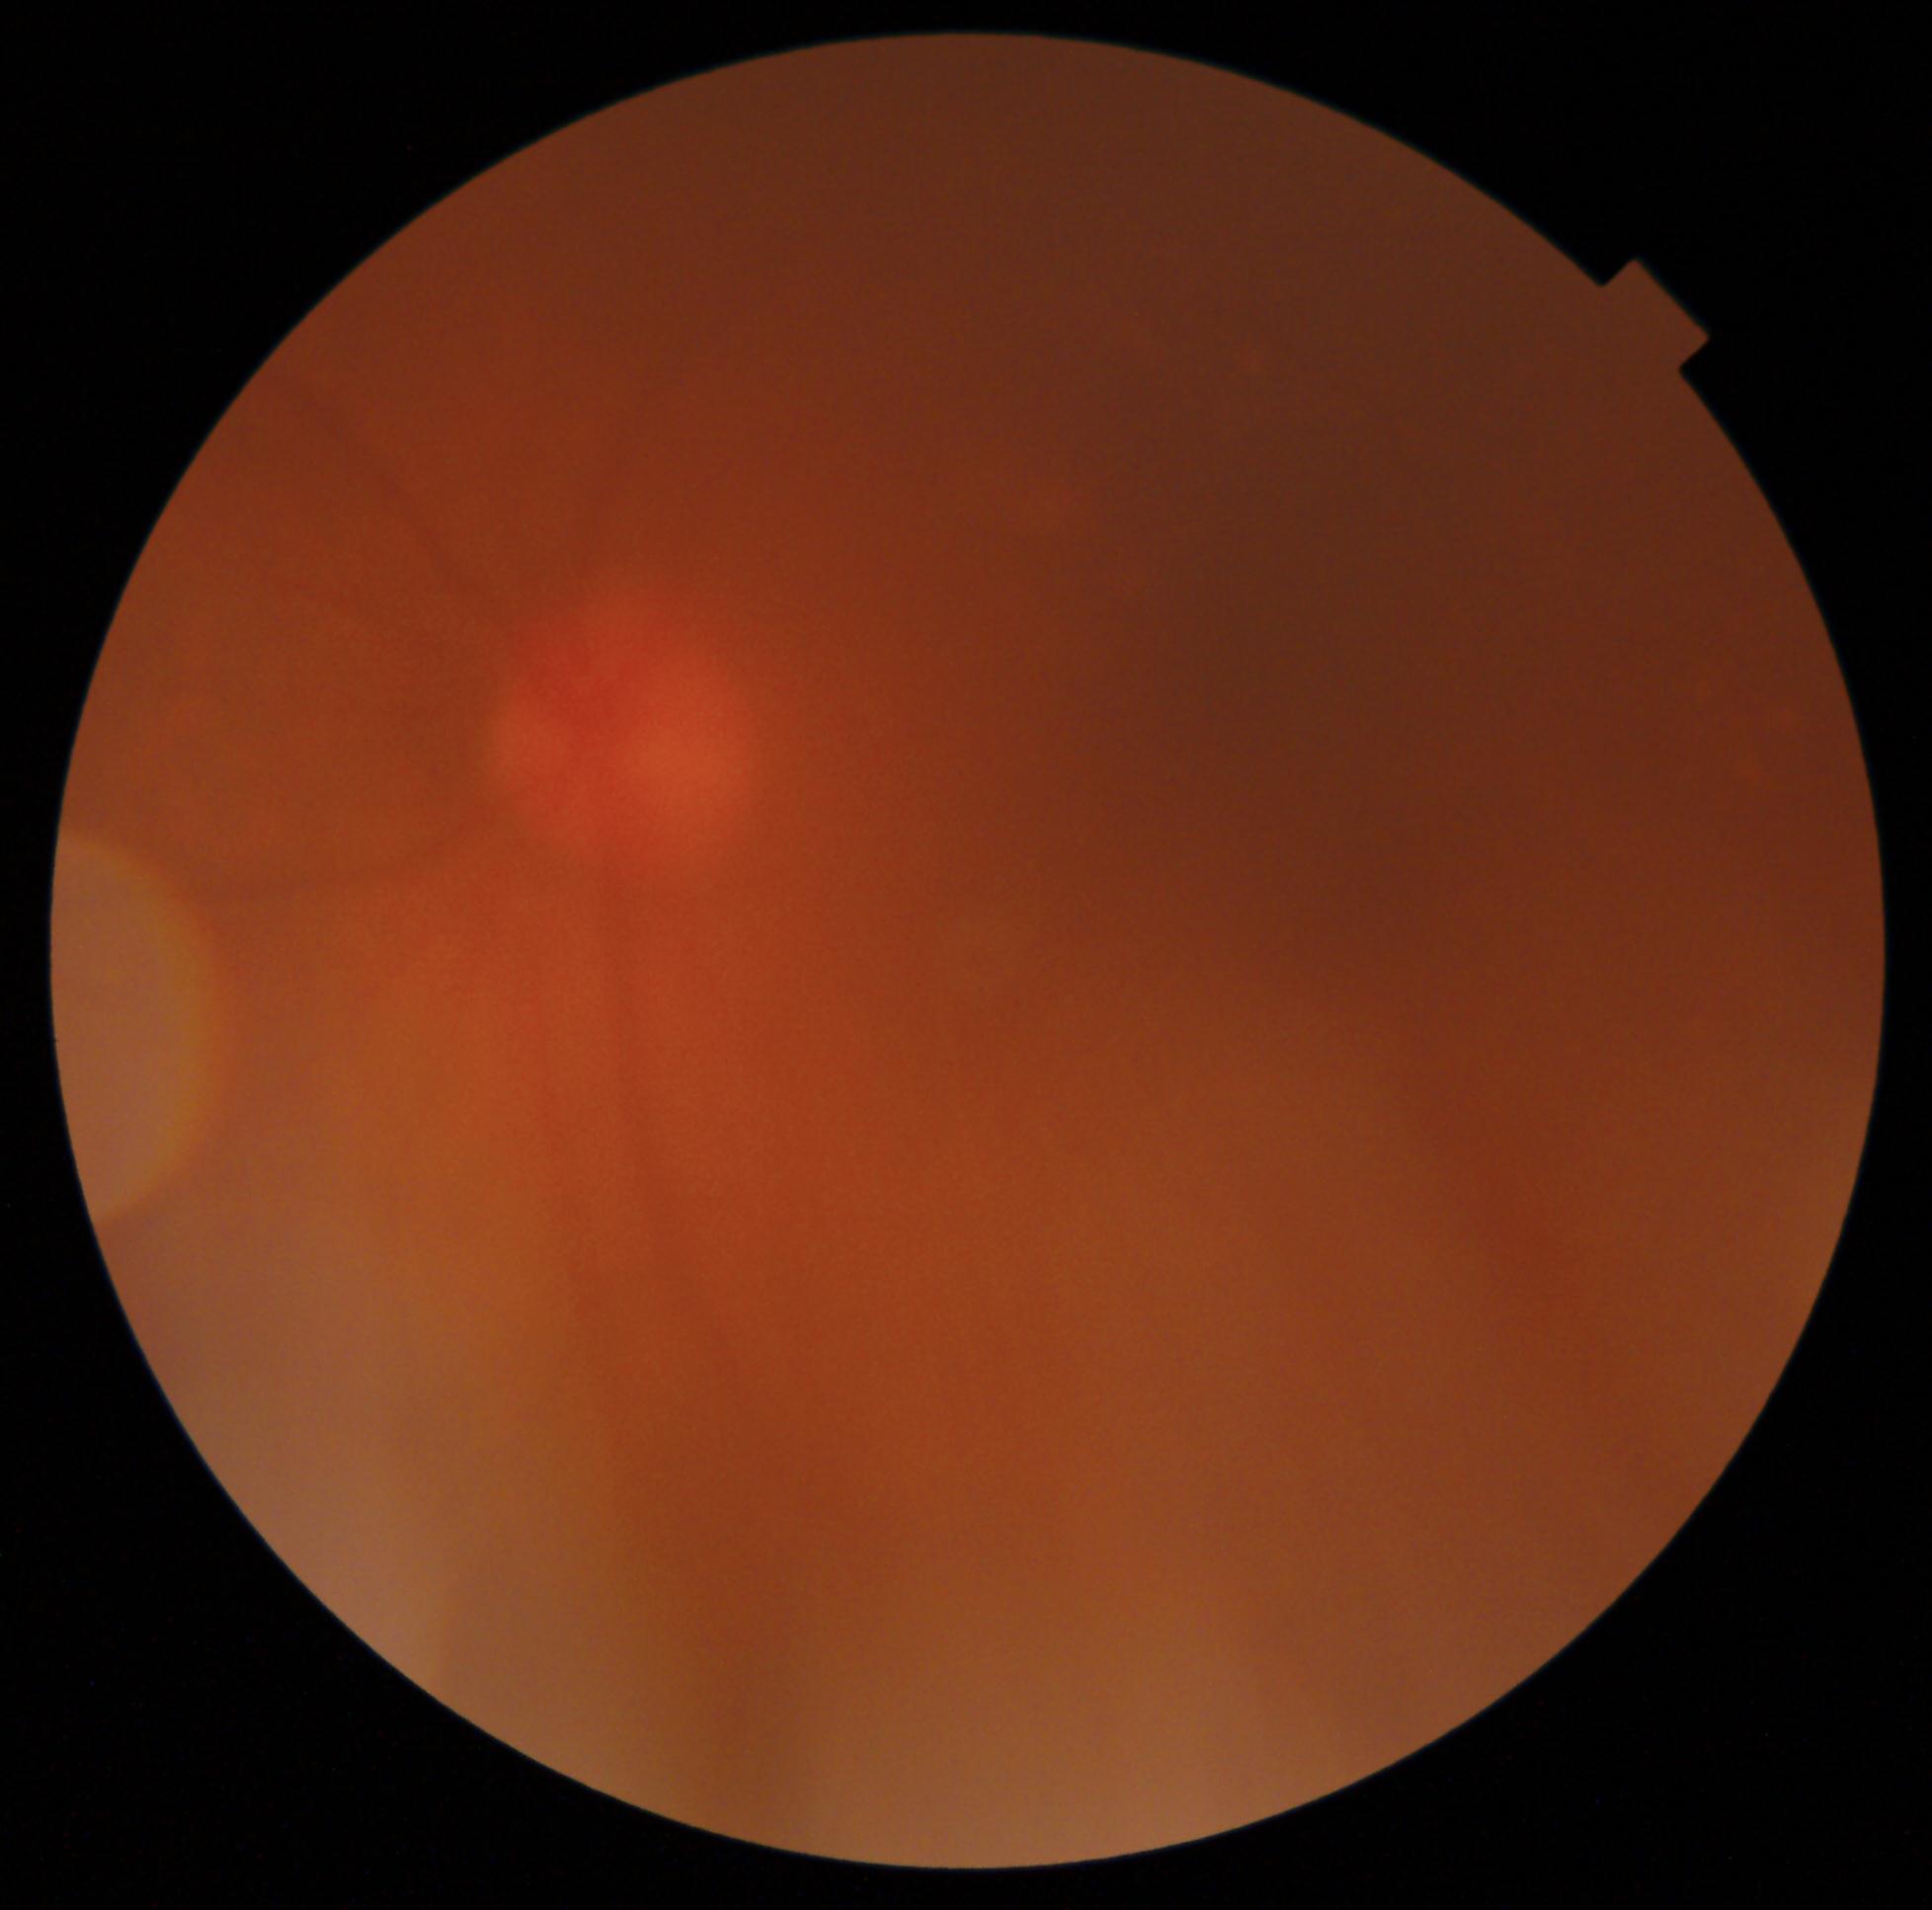 Diabetic retinopathy (DR) is ungradable due to poor image quality.
Quality too poor to assess for DR.